Color fundus image:
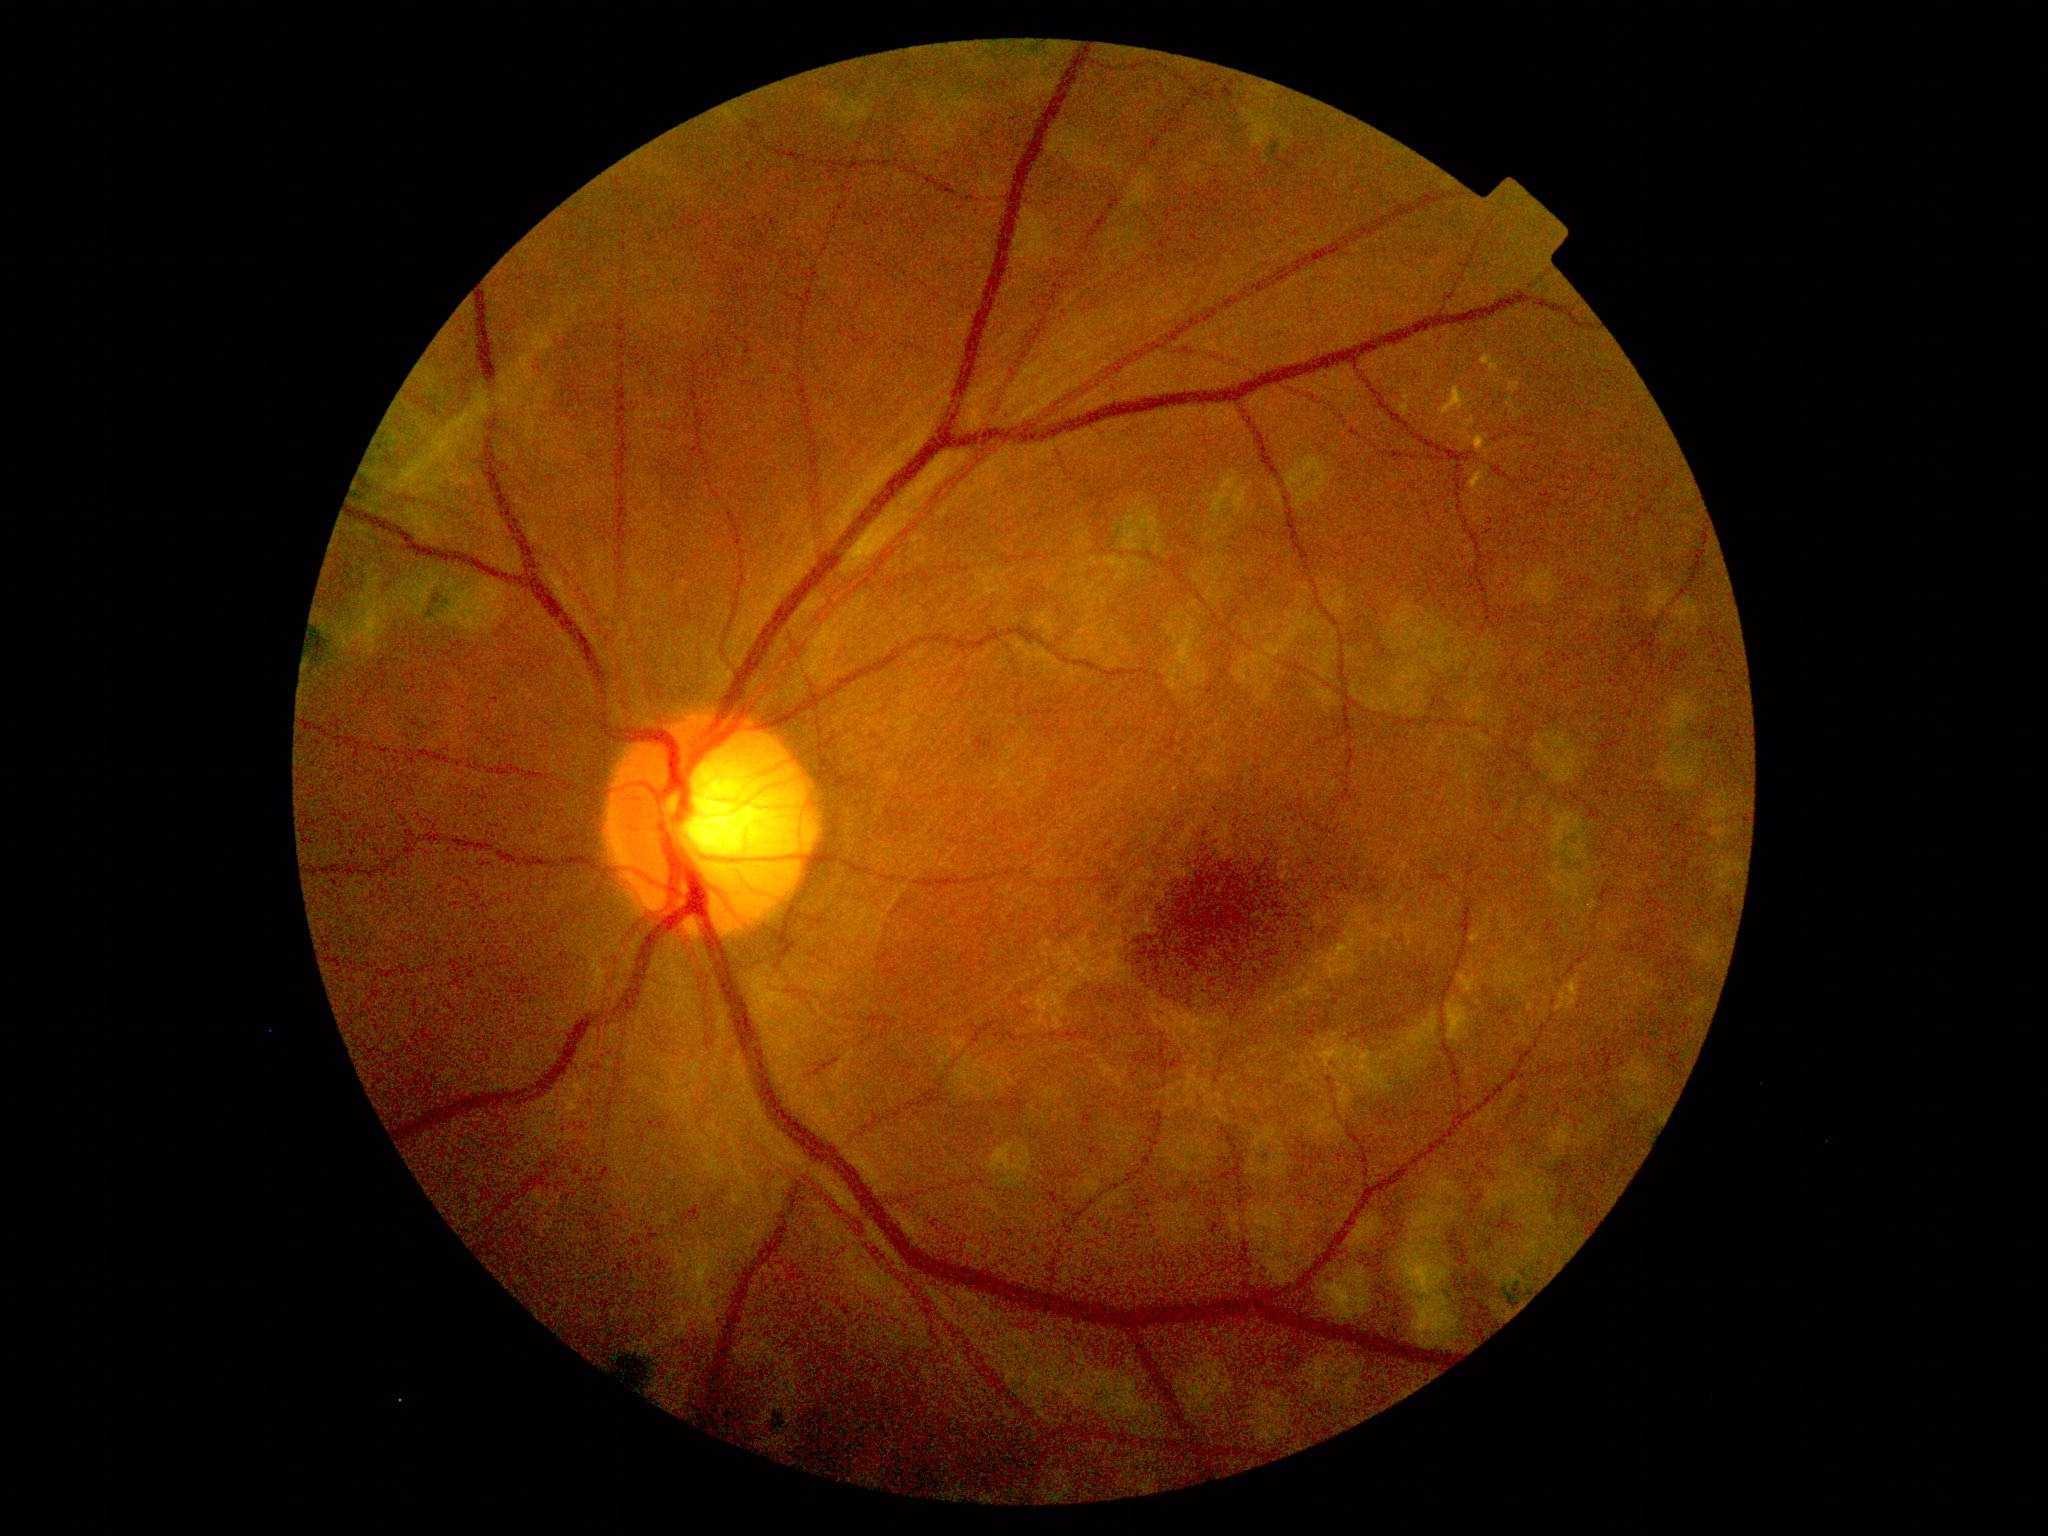

Diabetic retinopathy (DR) is grade 4 (PDR).